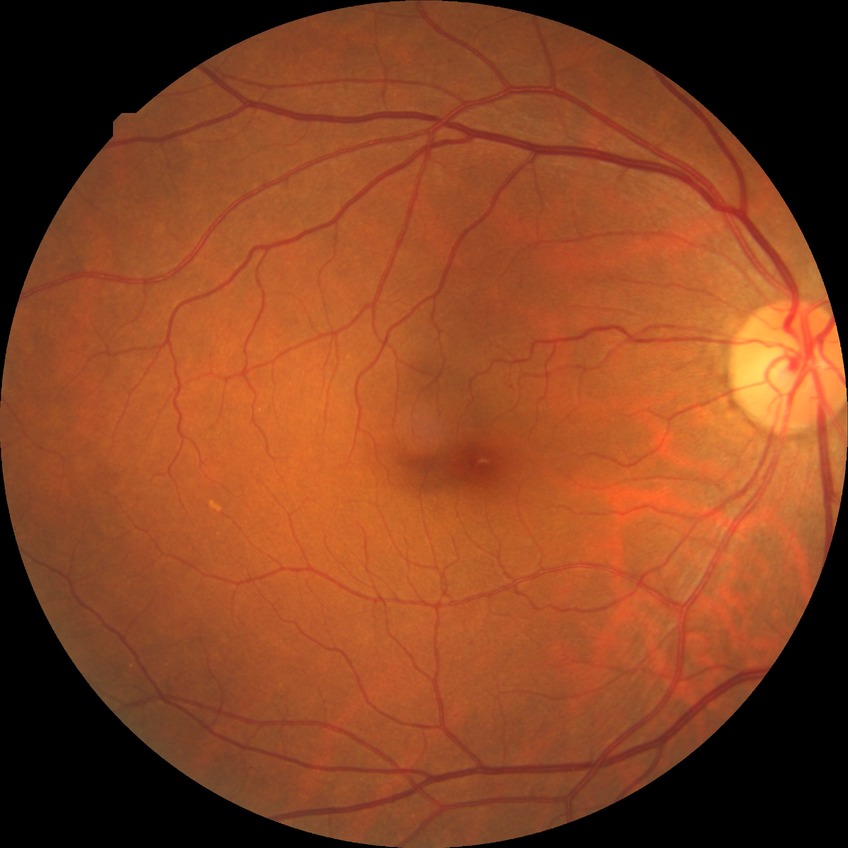
Diabetic retinopathy severity is no diabetic retinopathy.